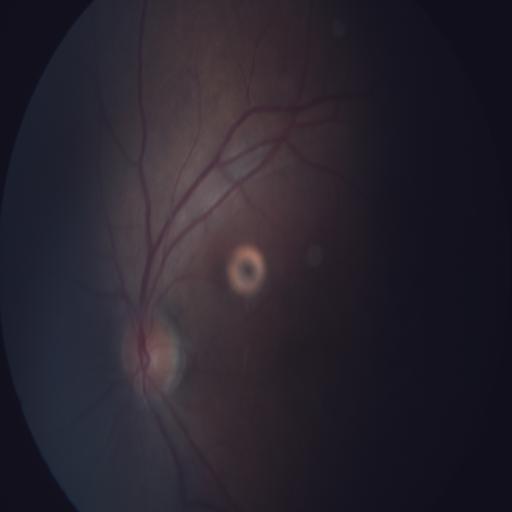

Diagnoses: optic disc edema (ODE).